Infant wide-field fundus photograph; 1240 x 1240 pixels; Phoenix ICON, 100° FOV — 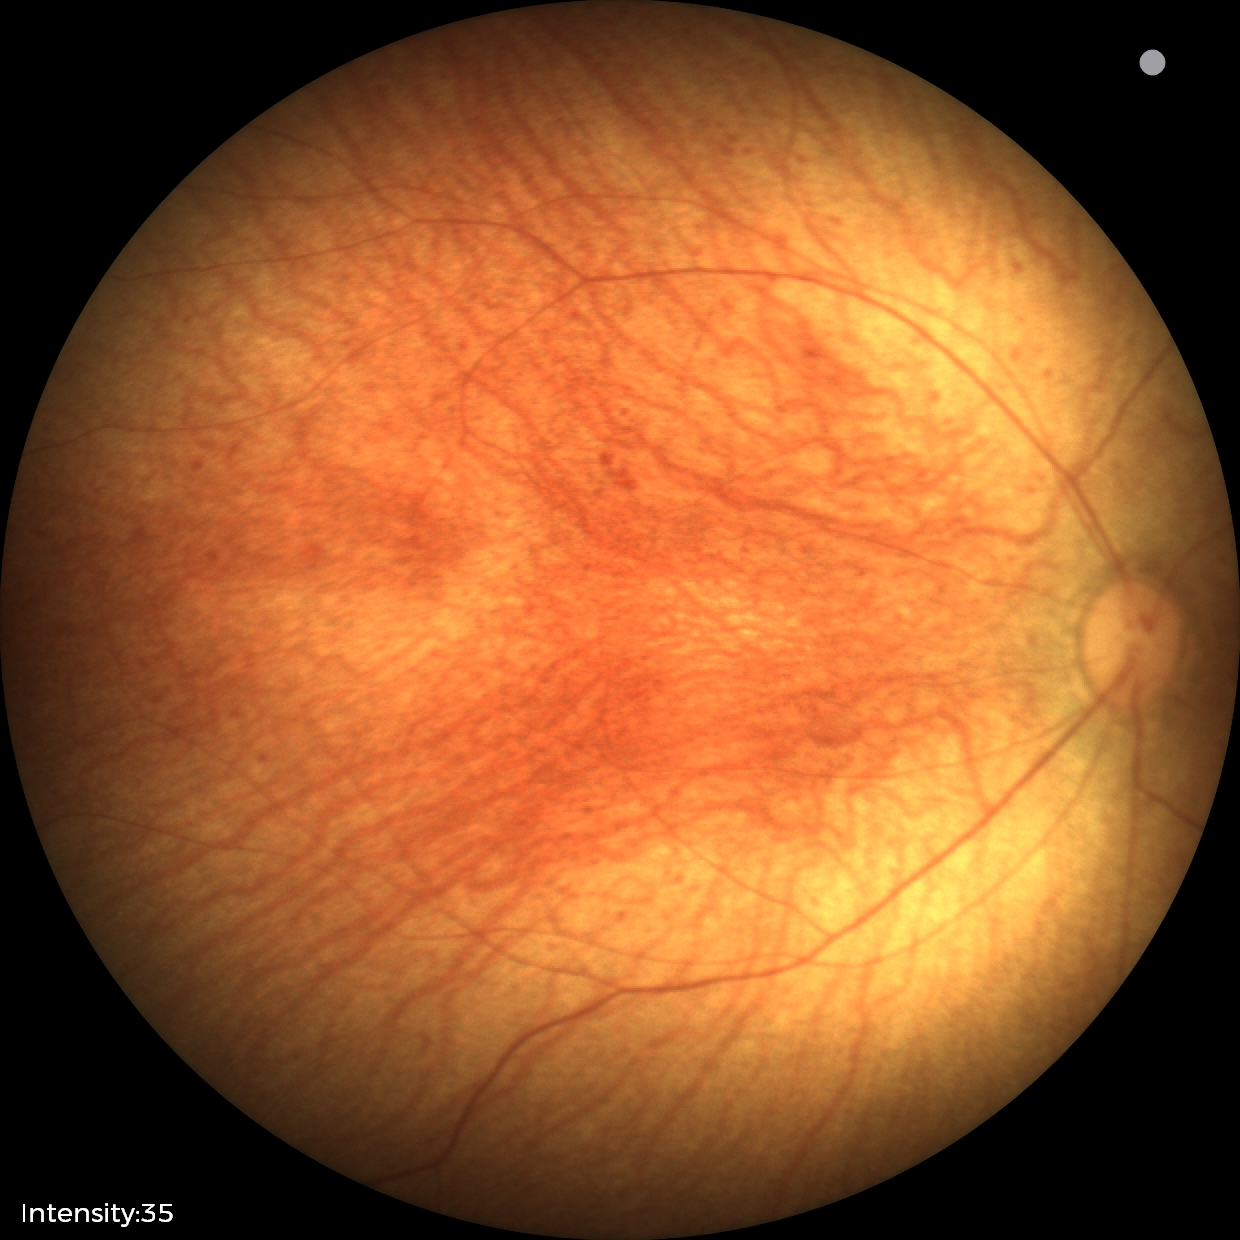

Screening examination with no abnormal retinal findings.